Retinal fundus photograph; FOV: 50 degrees — 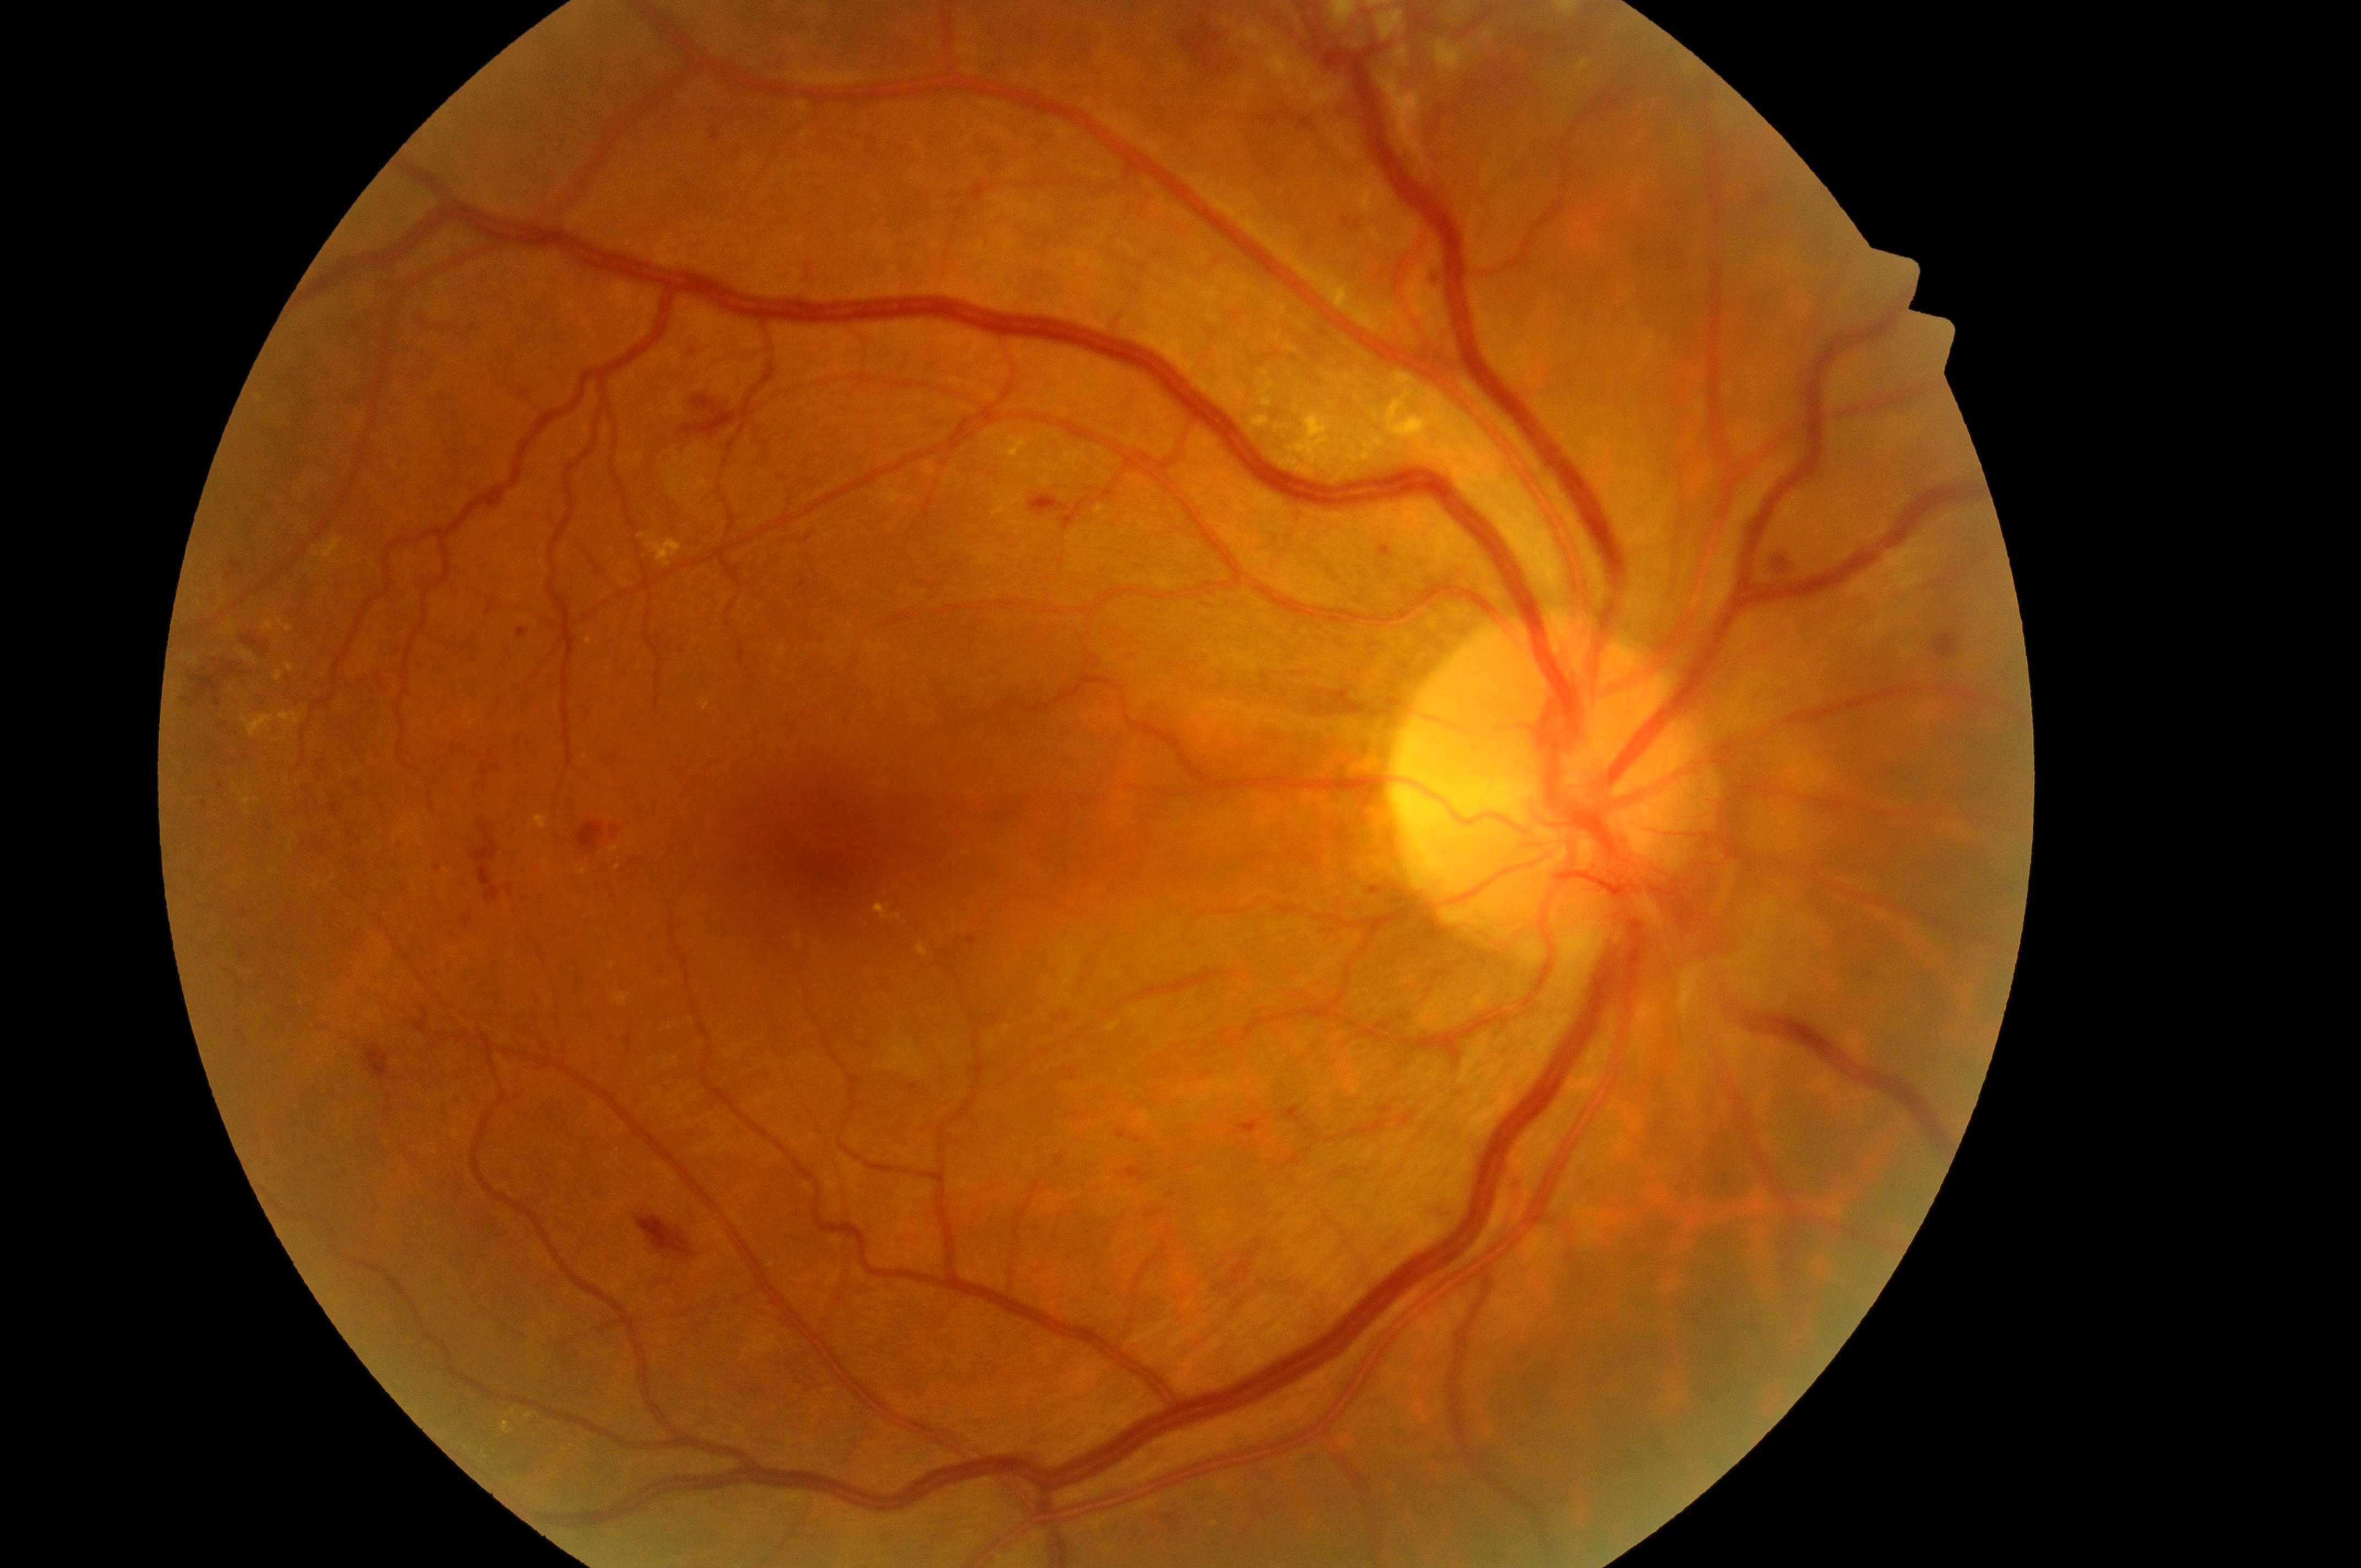 Annotations:
- retinopathy grade — 4/4
- fovea centralis — (839,831)
- laterality — right eye
- optic disk — (1535,798)
- macular edema risk — 2
- DR class — proliferative diabetic retinopathy